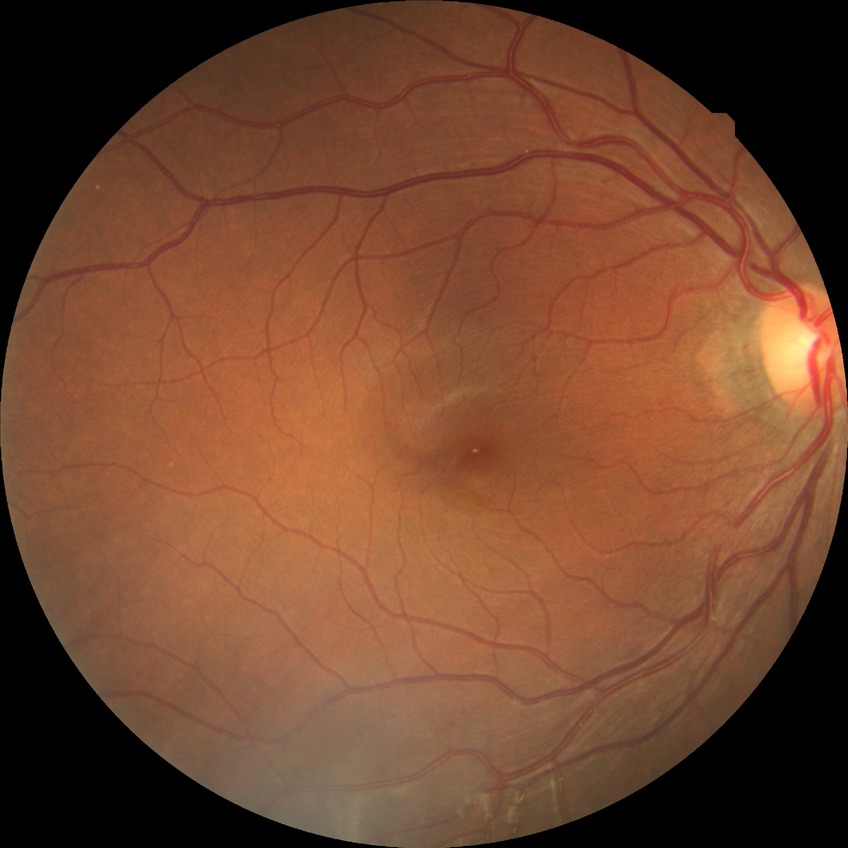

DR grade=NDR.